Fundus photo:
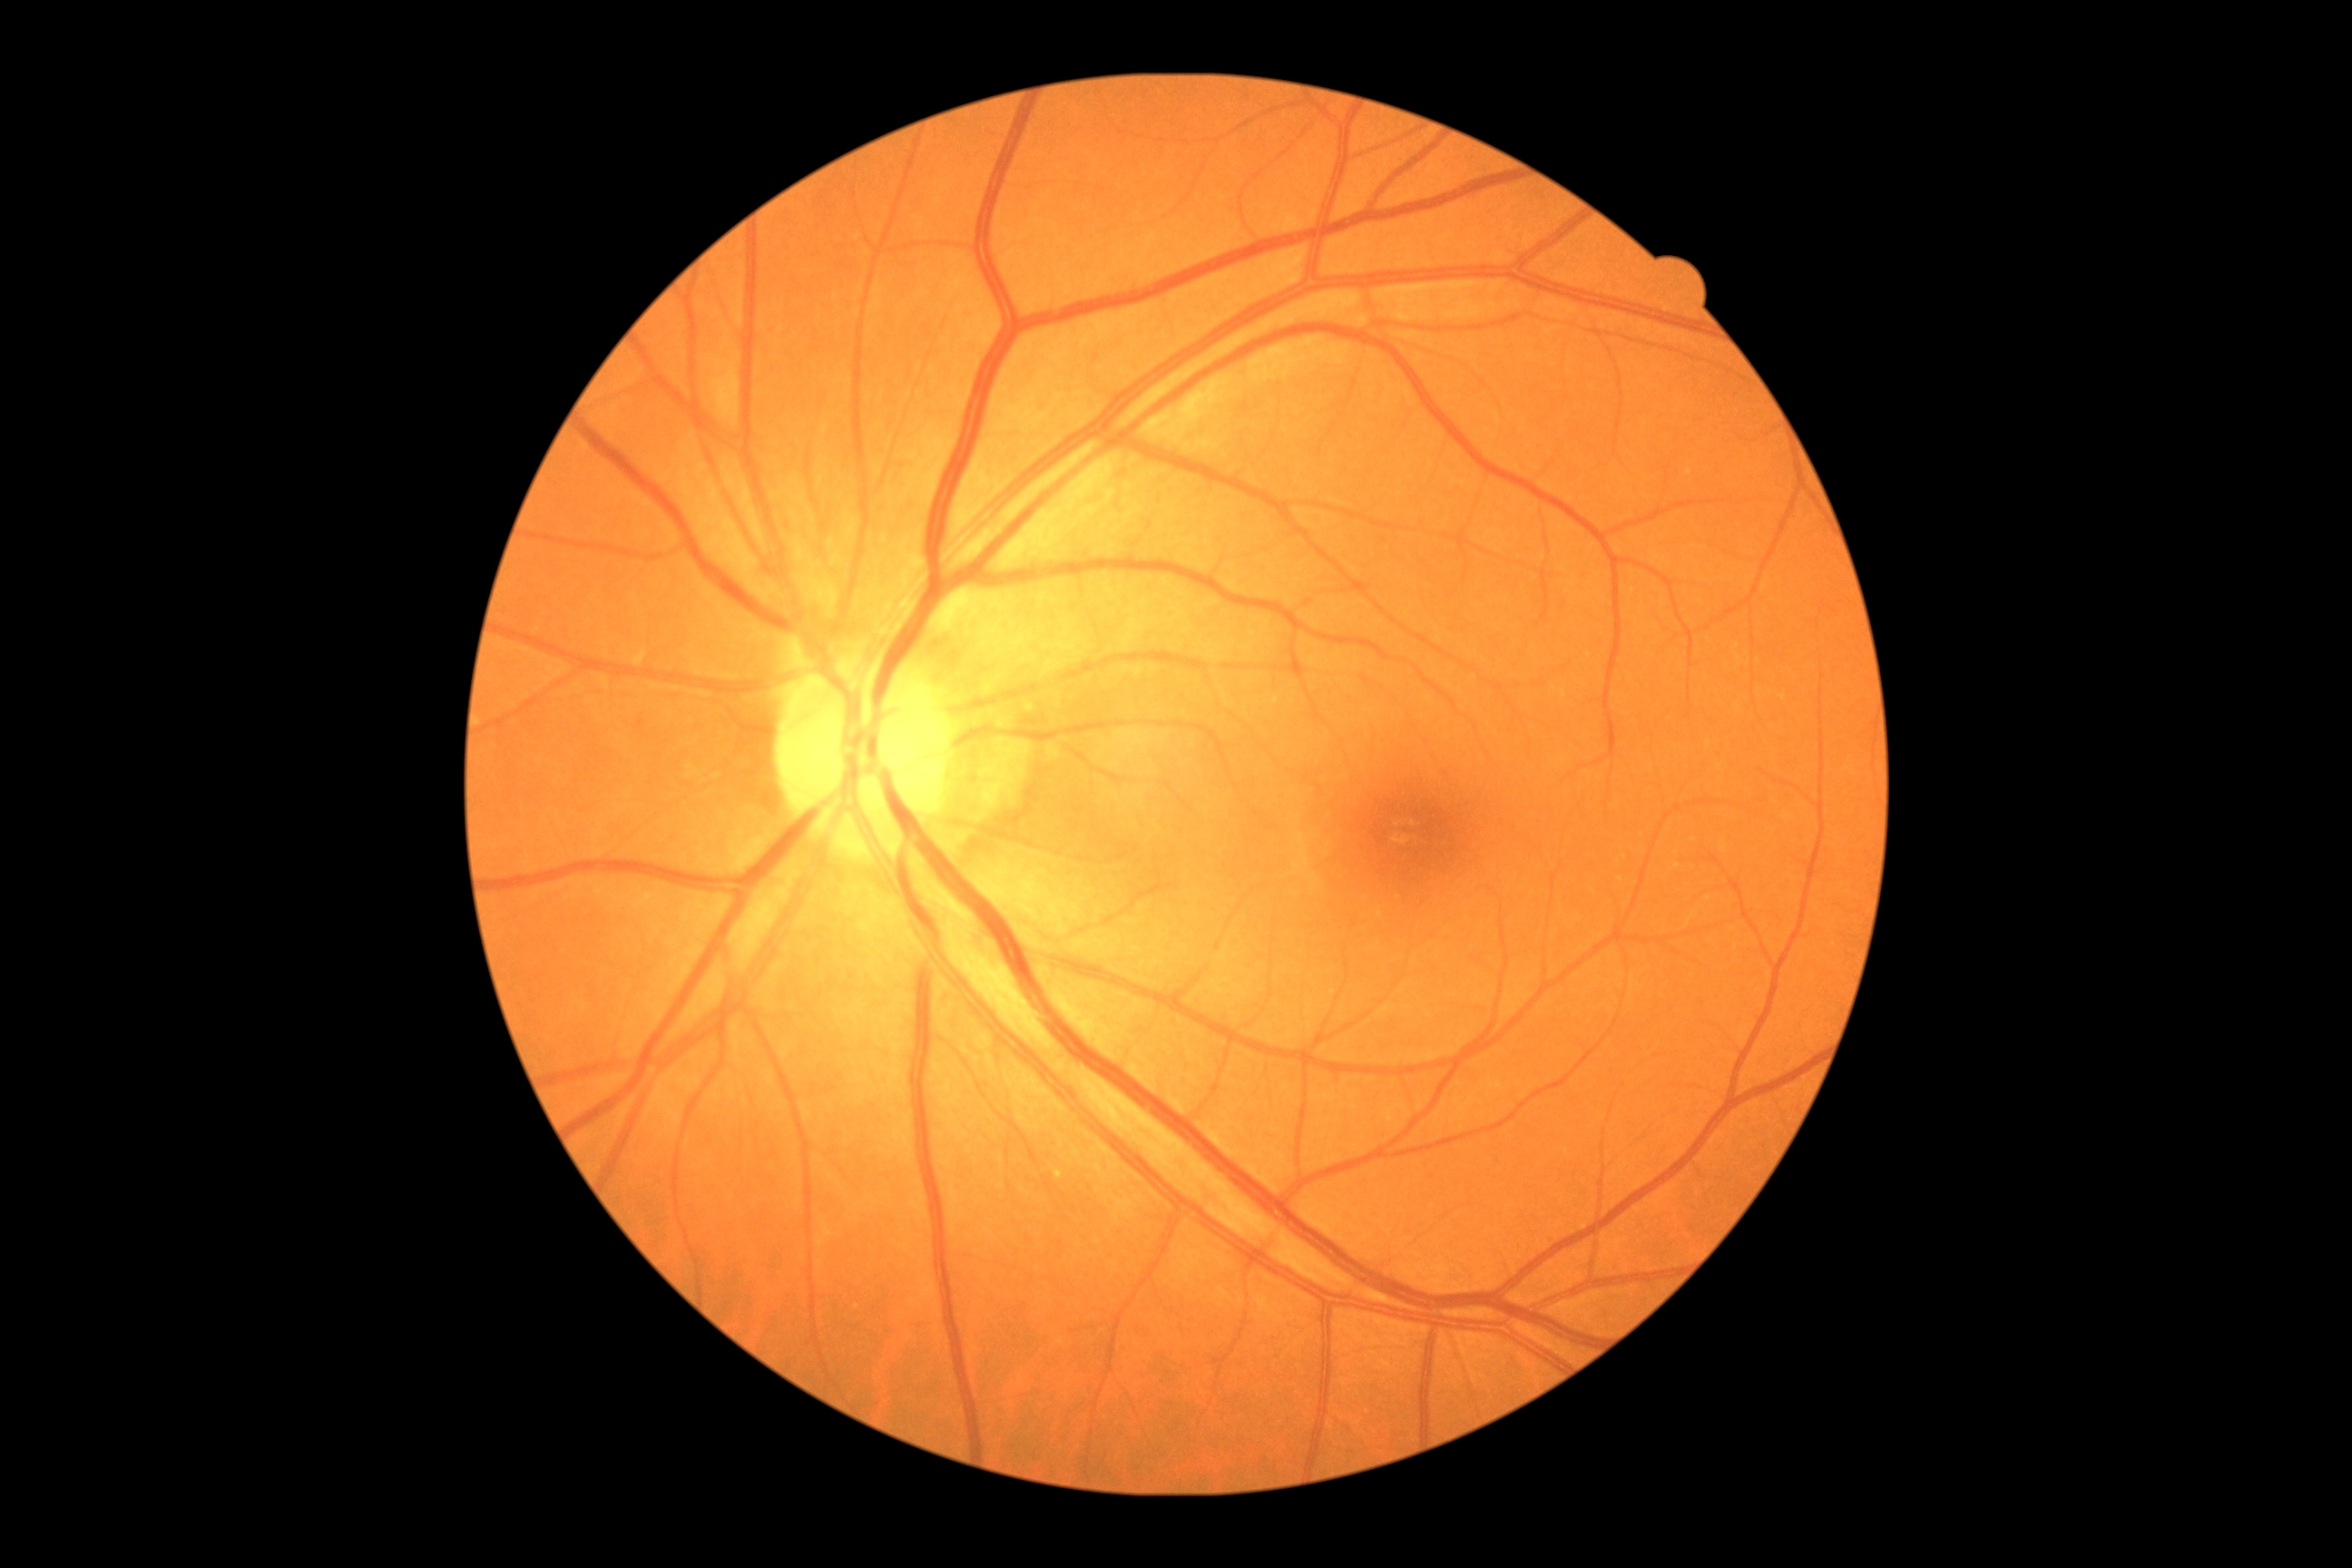
Diabetic retinopathy (DR): no apparent diabetic retinopathy (grade 0). No signs of diabetic retinopathy.